Phoenix ICON wide-field infant fundus image:
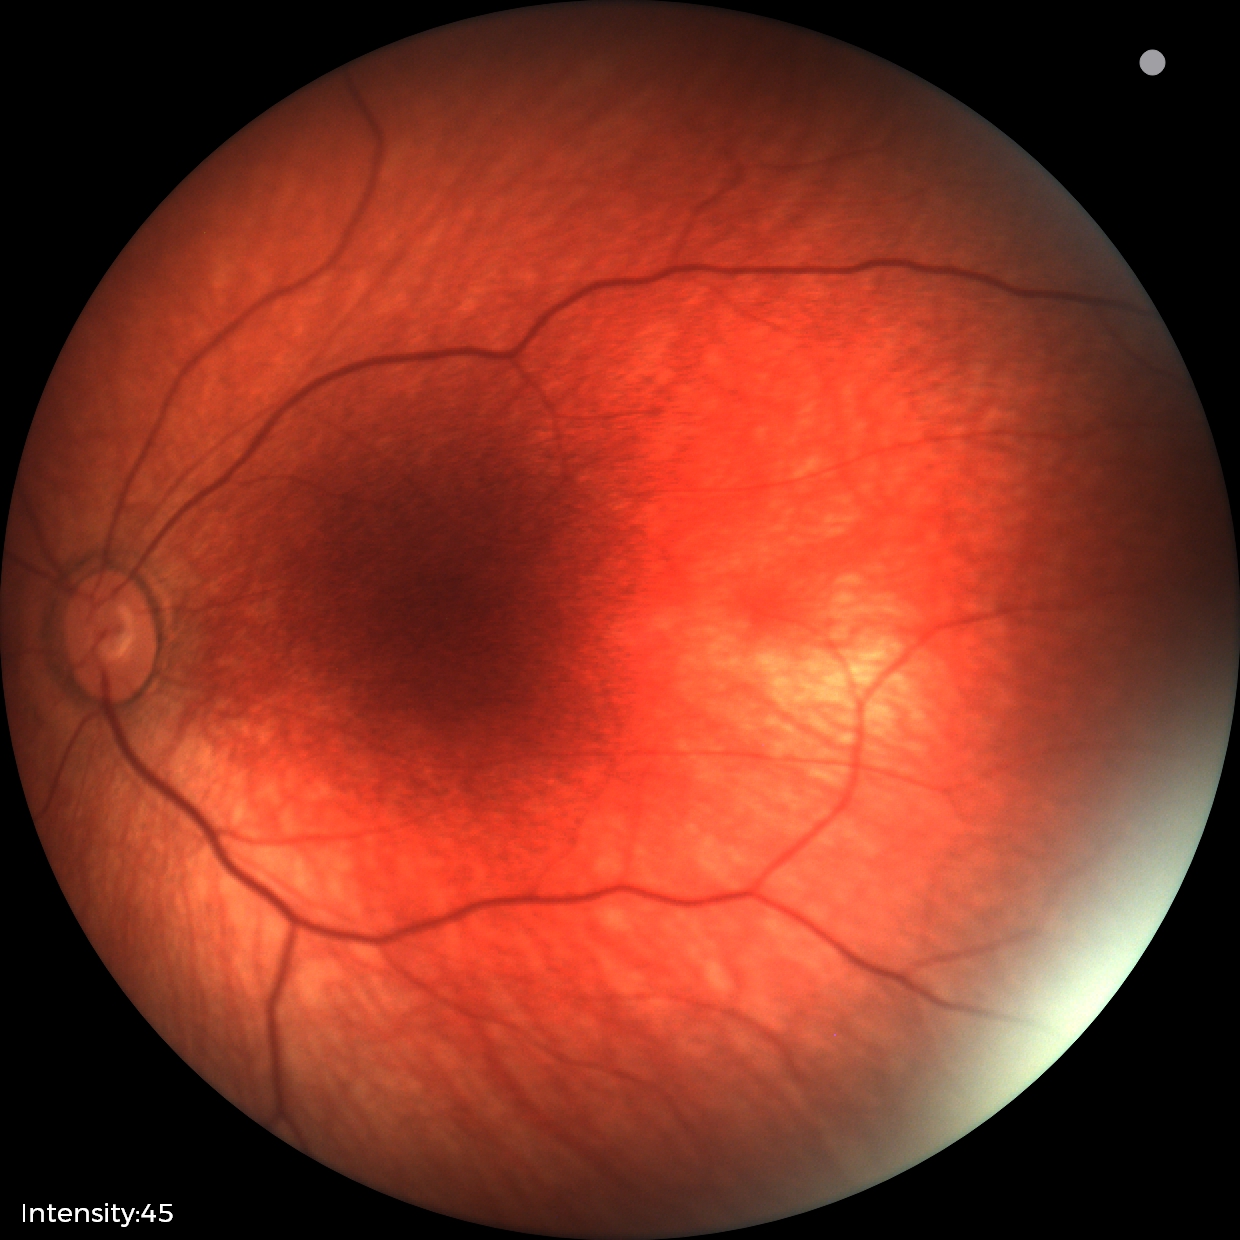 Examination with physiological retinal findings.